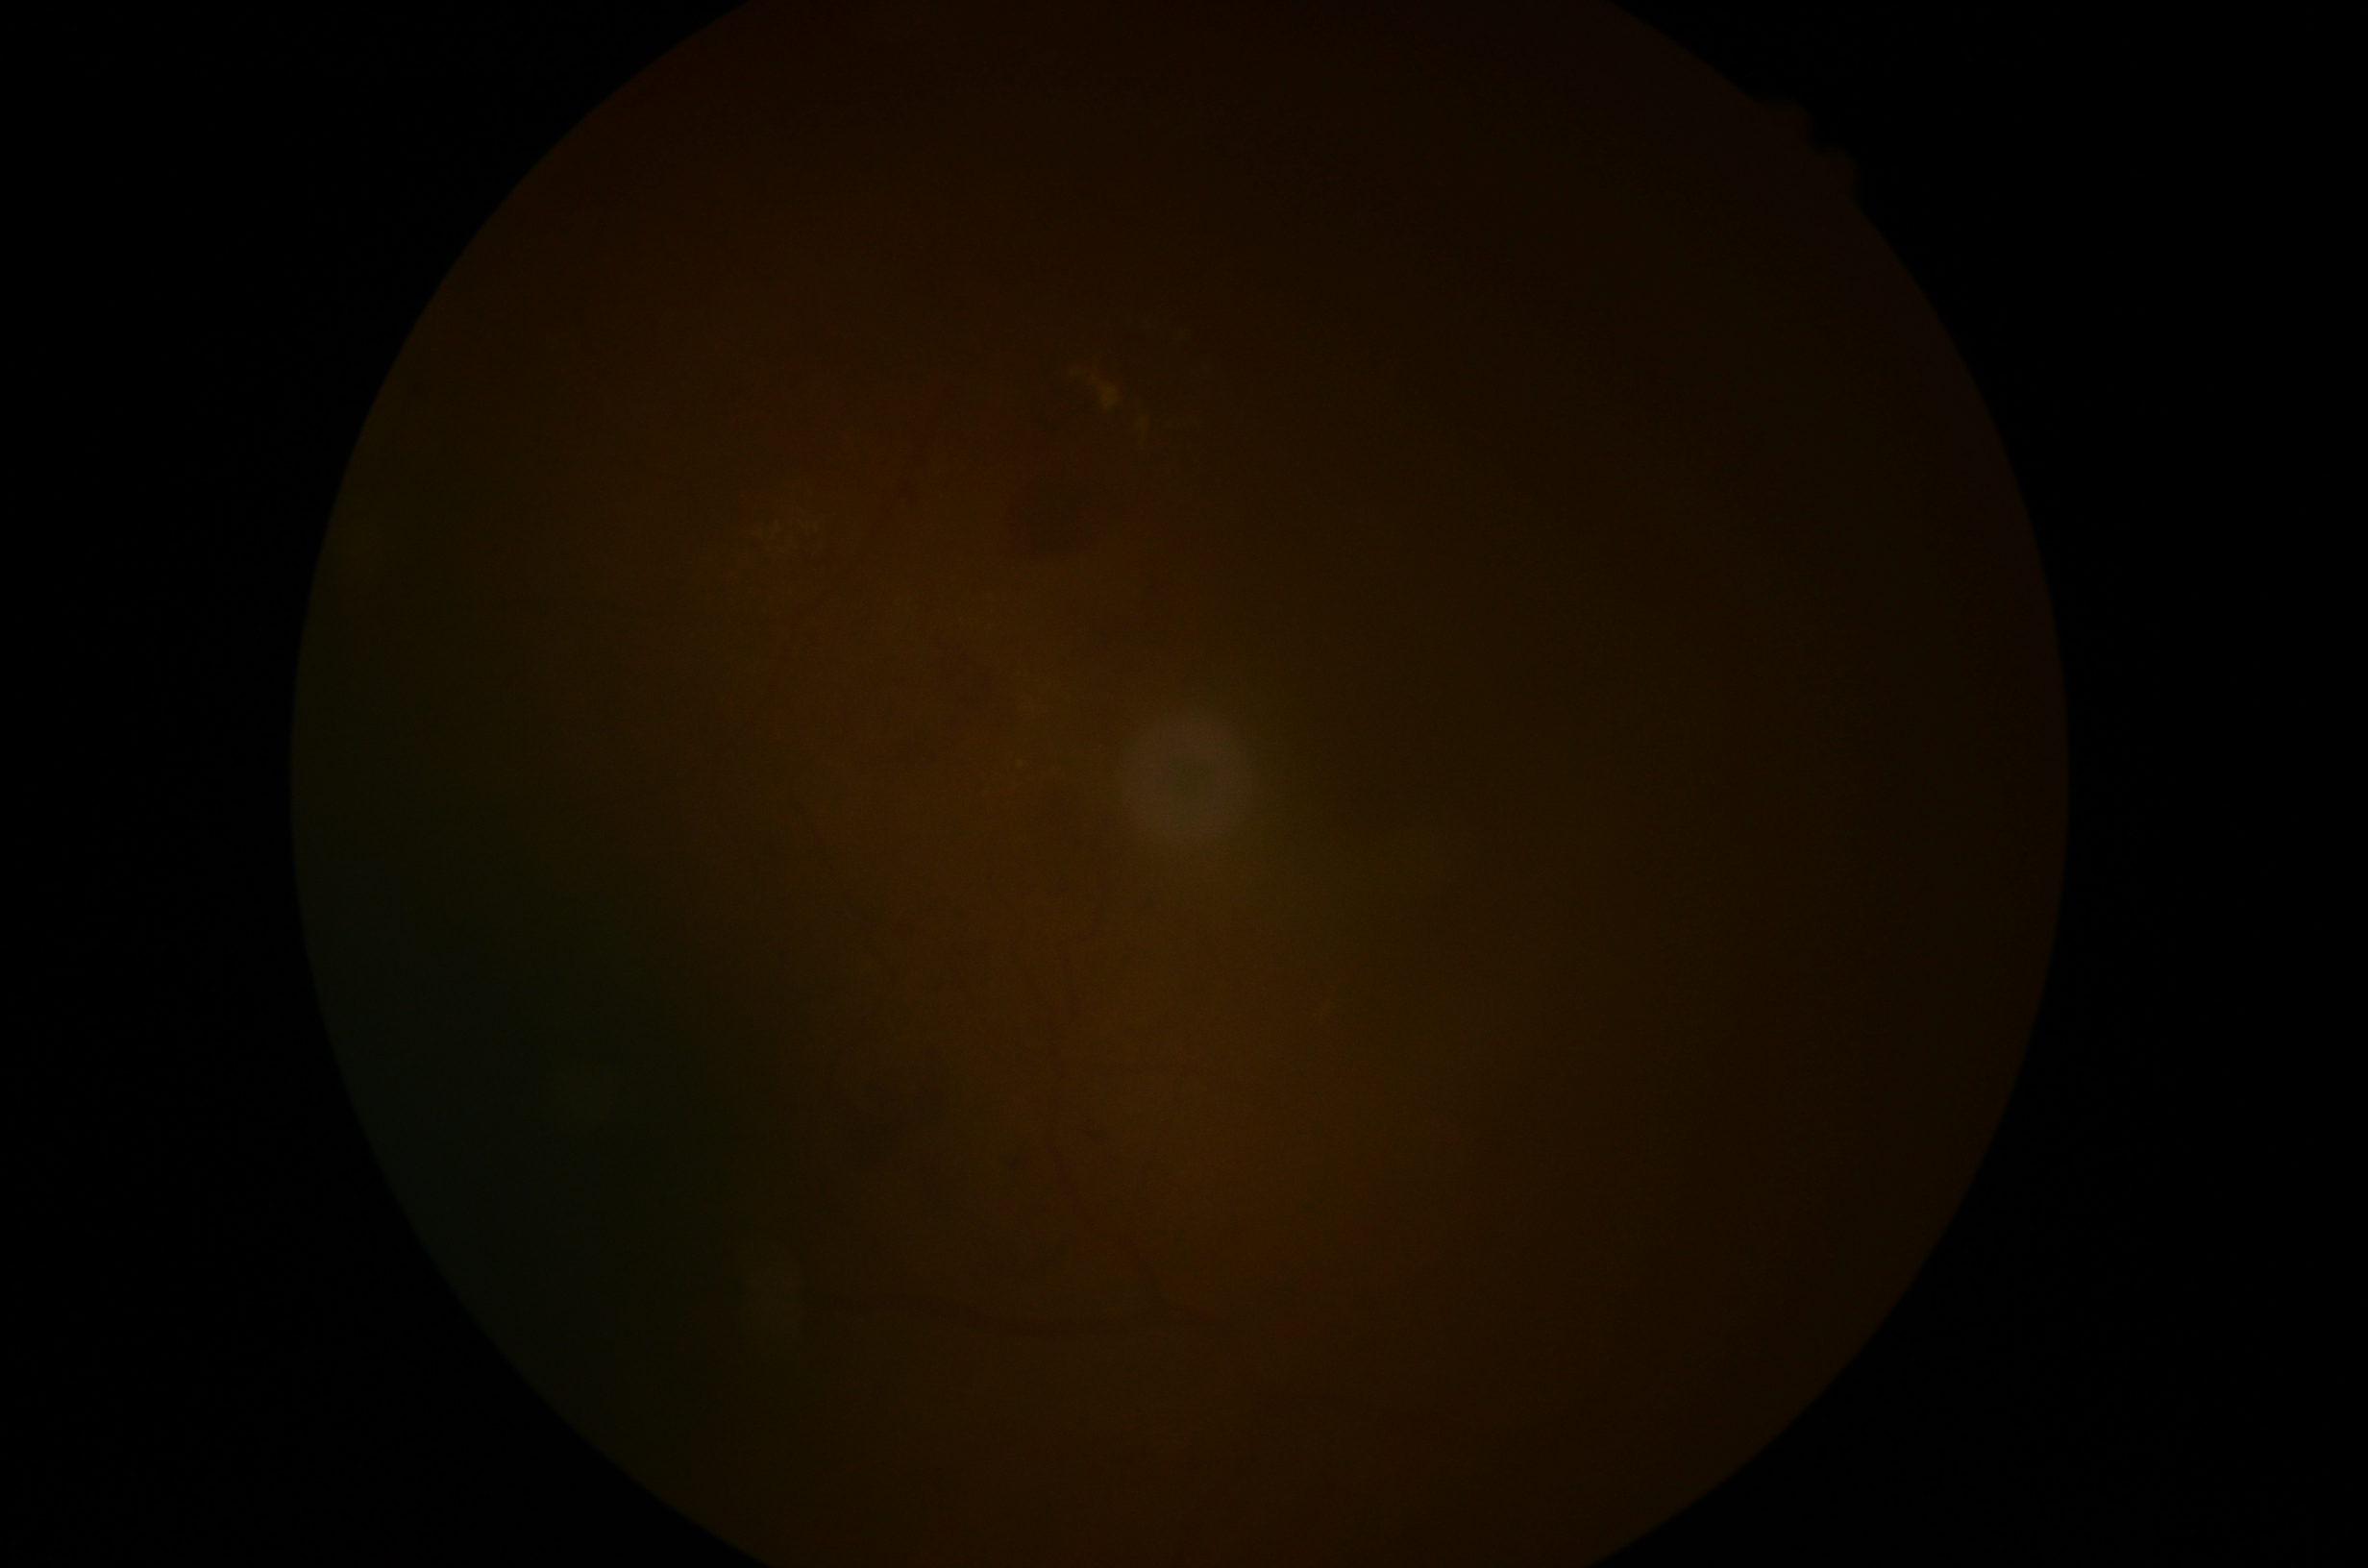
DR grade is ungradable due to poor image quality.
Image quality is insufficient for diabetic retinopathy assessment.